Pediatric wide-field fundus photograph
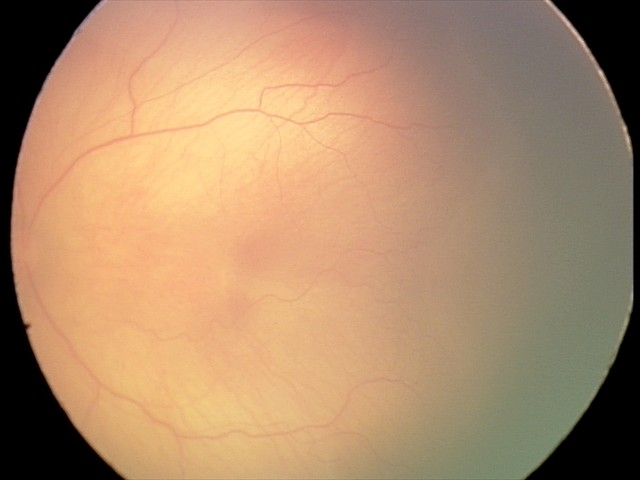
Plus disease absent. From an examination with diagnosis of retinopathy of prematurity (ROP) stage 1.